Pediatric retinal photograph (wide-field):
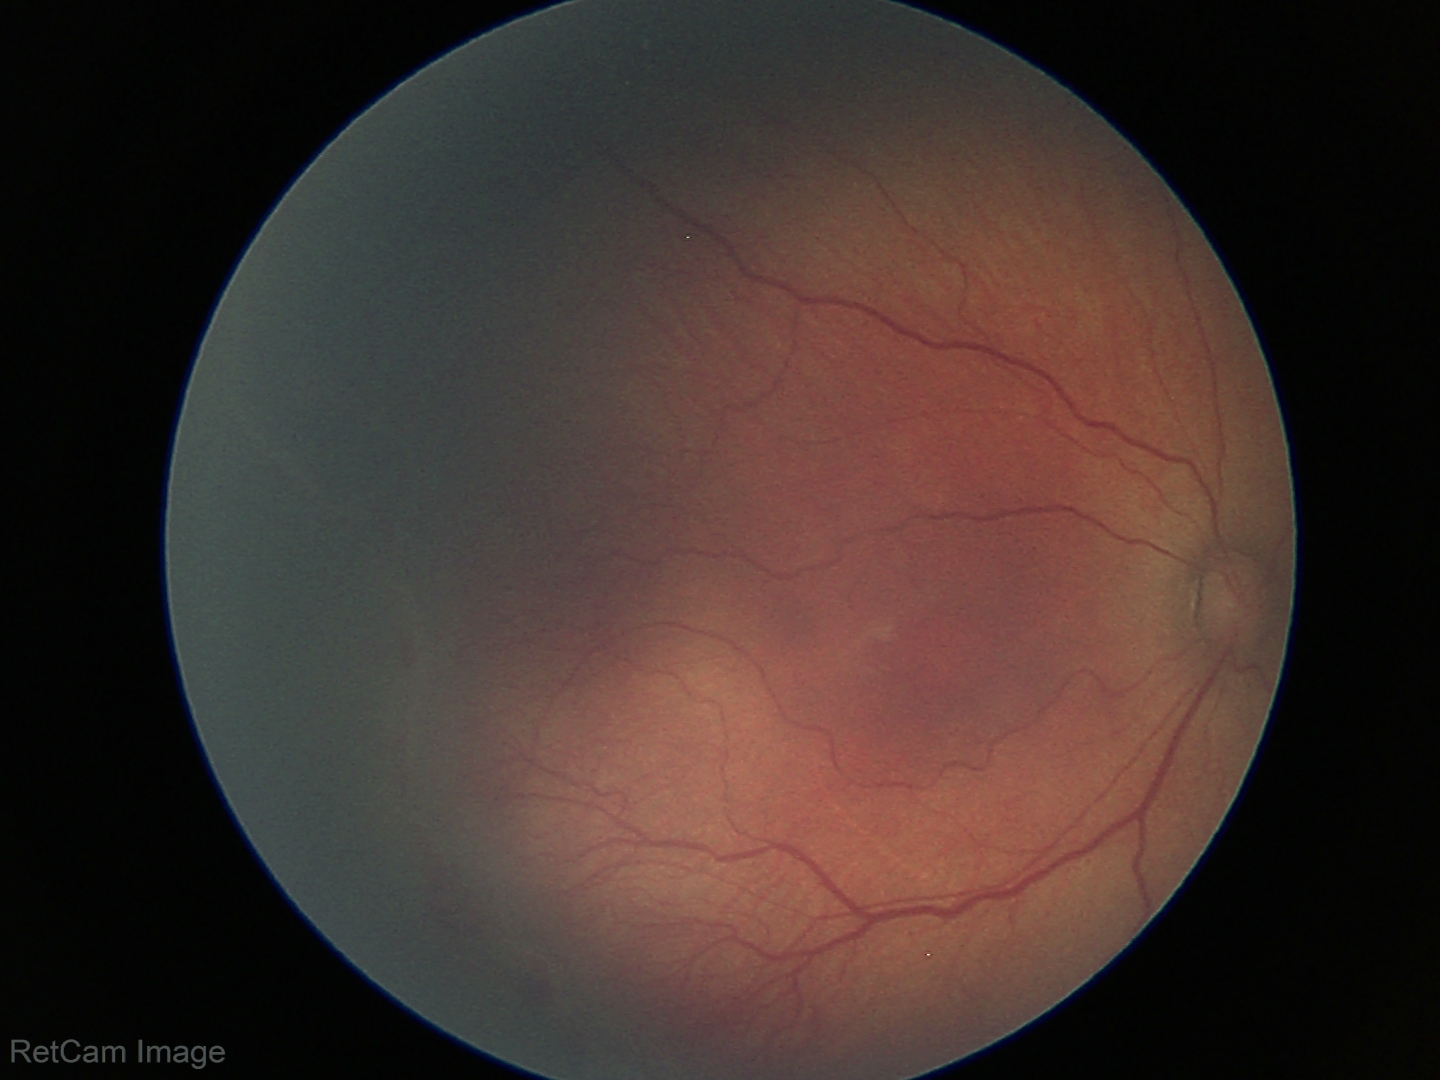

Examination diagnosed as retinopathy of prematurity stage 2.
No plus disease.